Retinal fundus photograph: 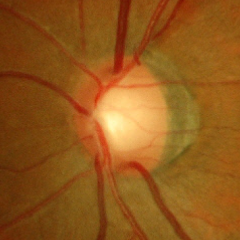
Q: Is glaucoma present?
A: Early-stage glaucoma. (Criteria: glaucomatous retinal nerve fiber layer defects on red-free fundus photography without visual field defects.)